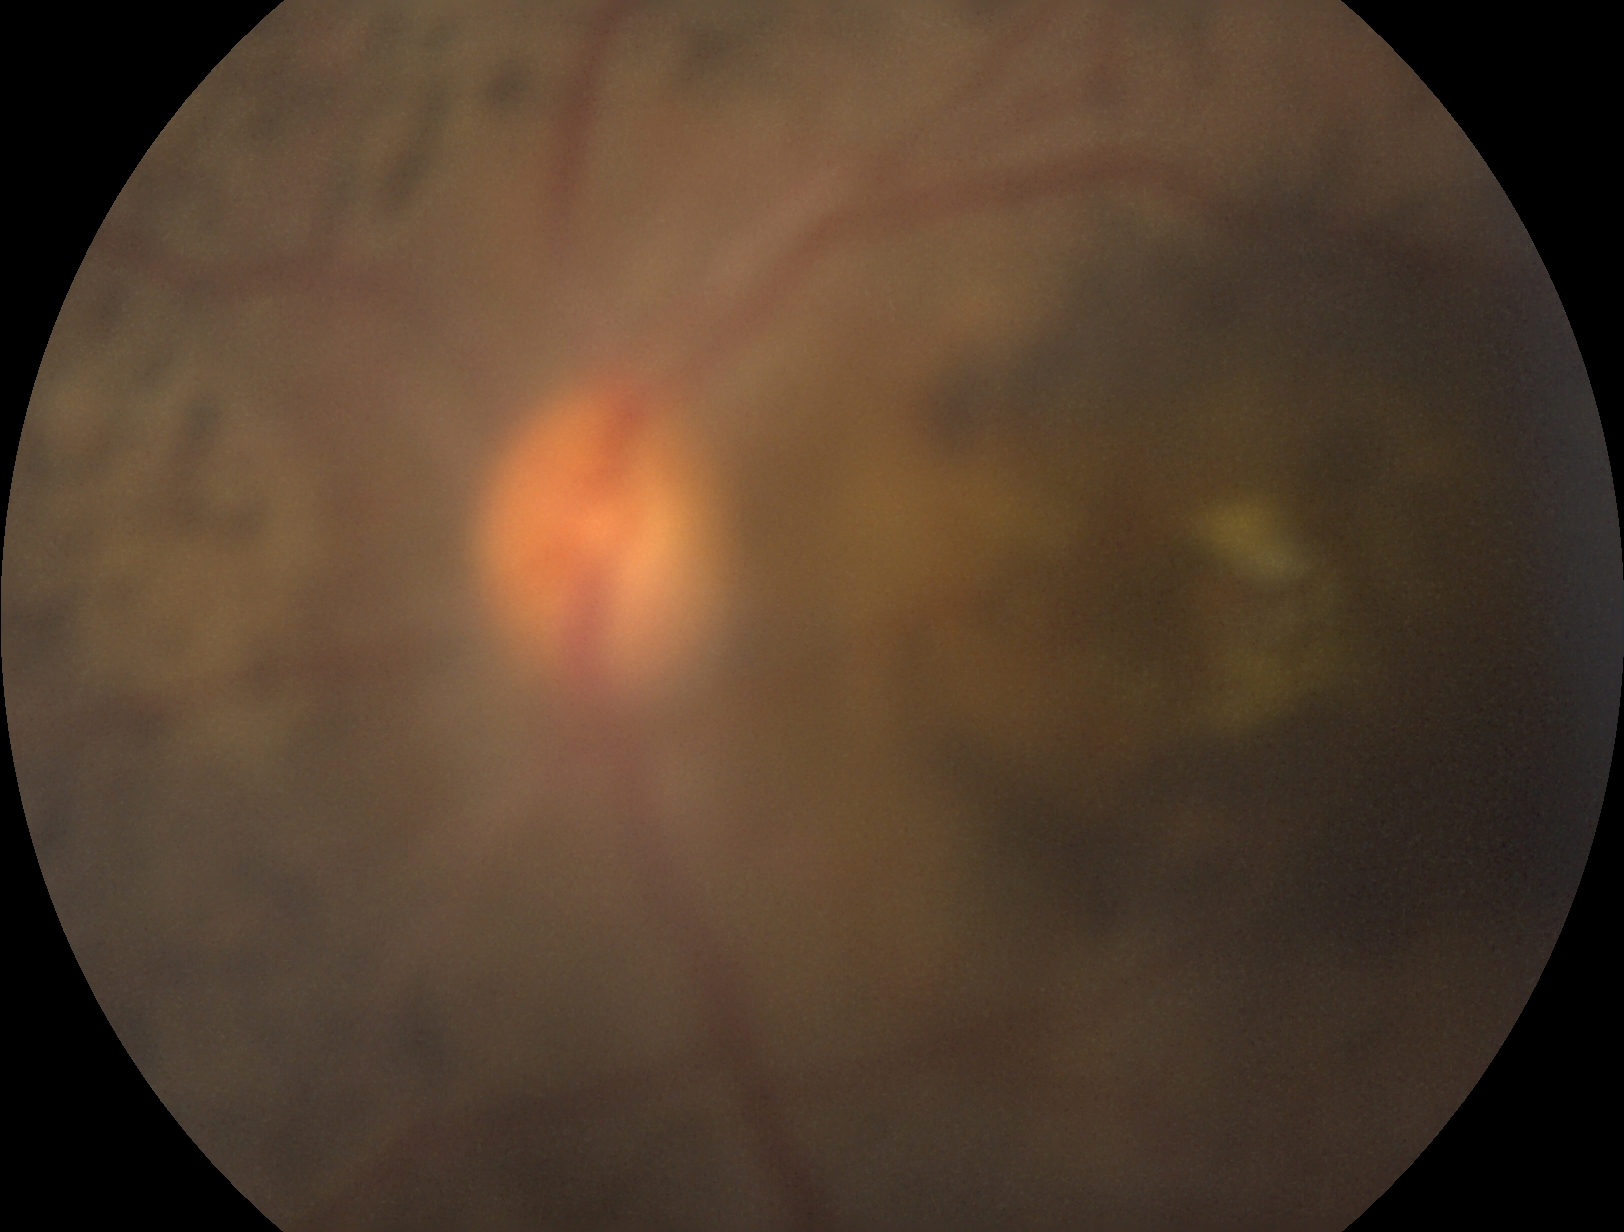

Diabetic retinopathy is ungradable due to poor image quality.